45° FOV, retinal fundus photograph.
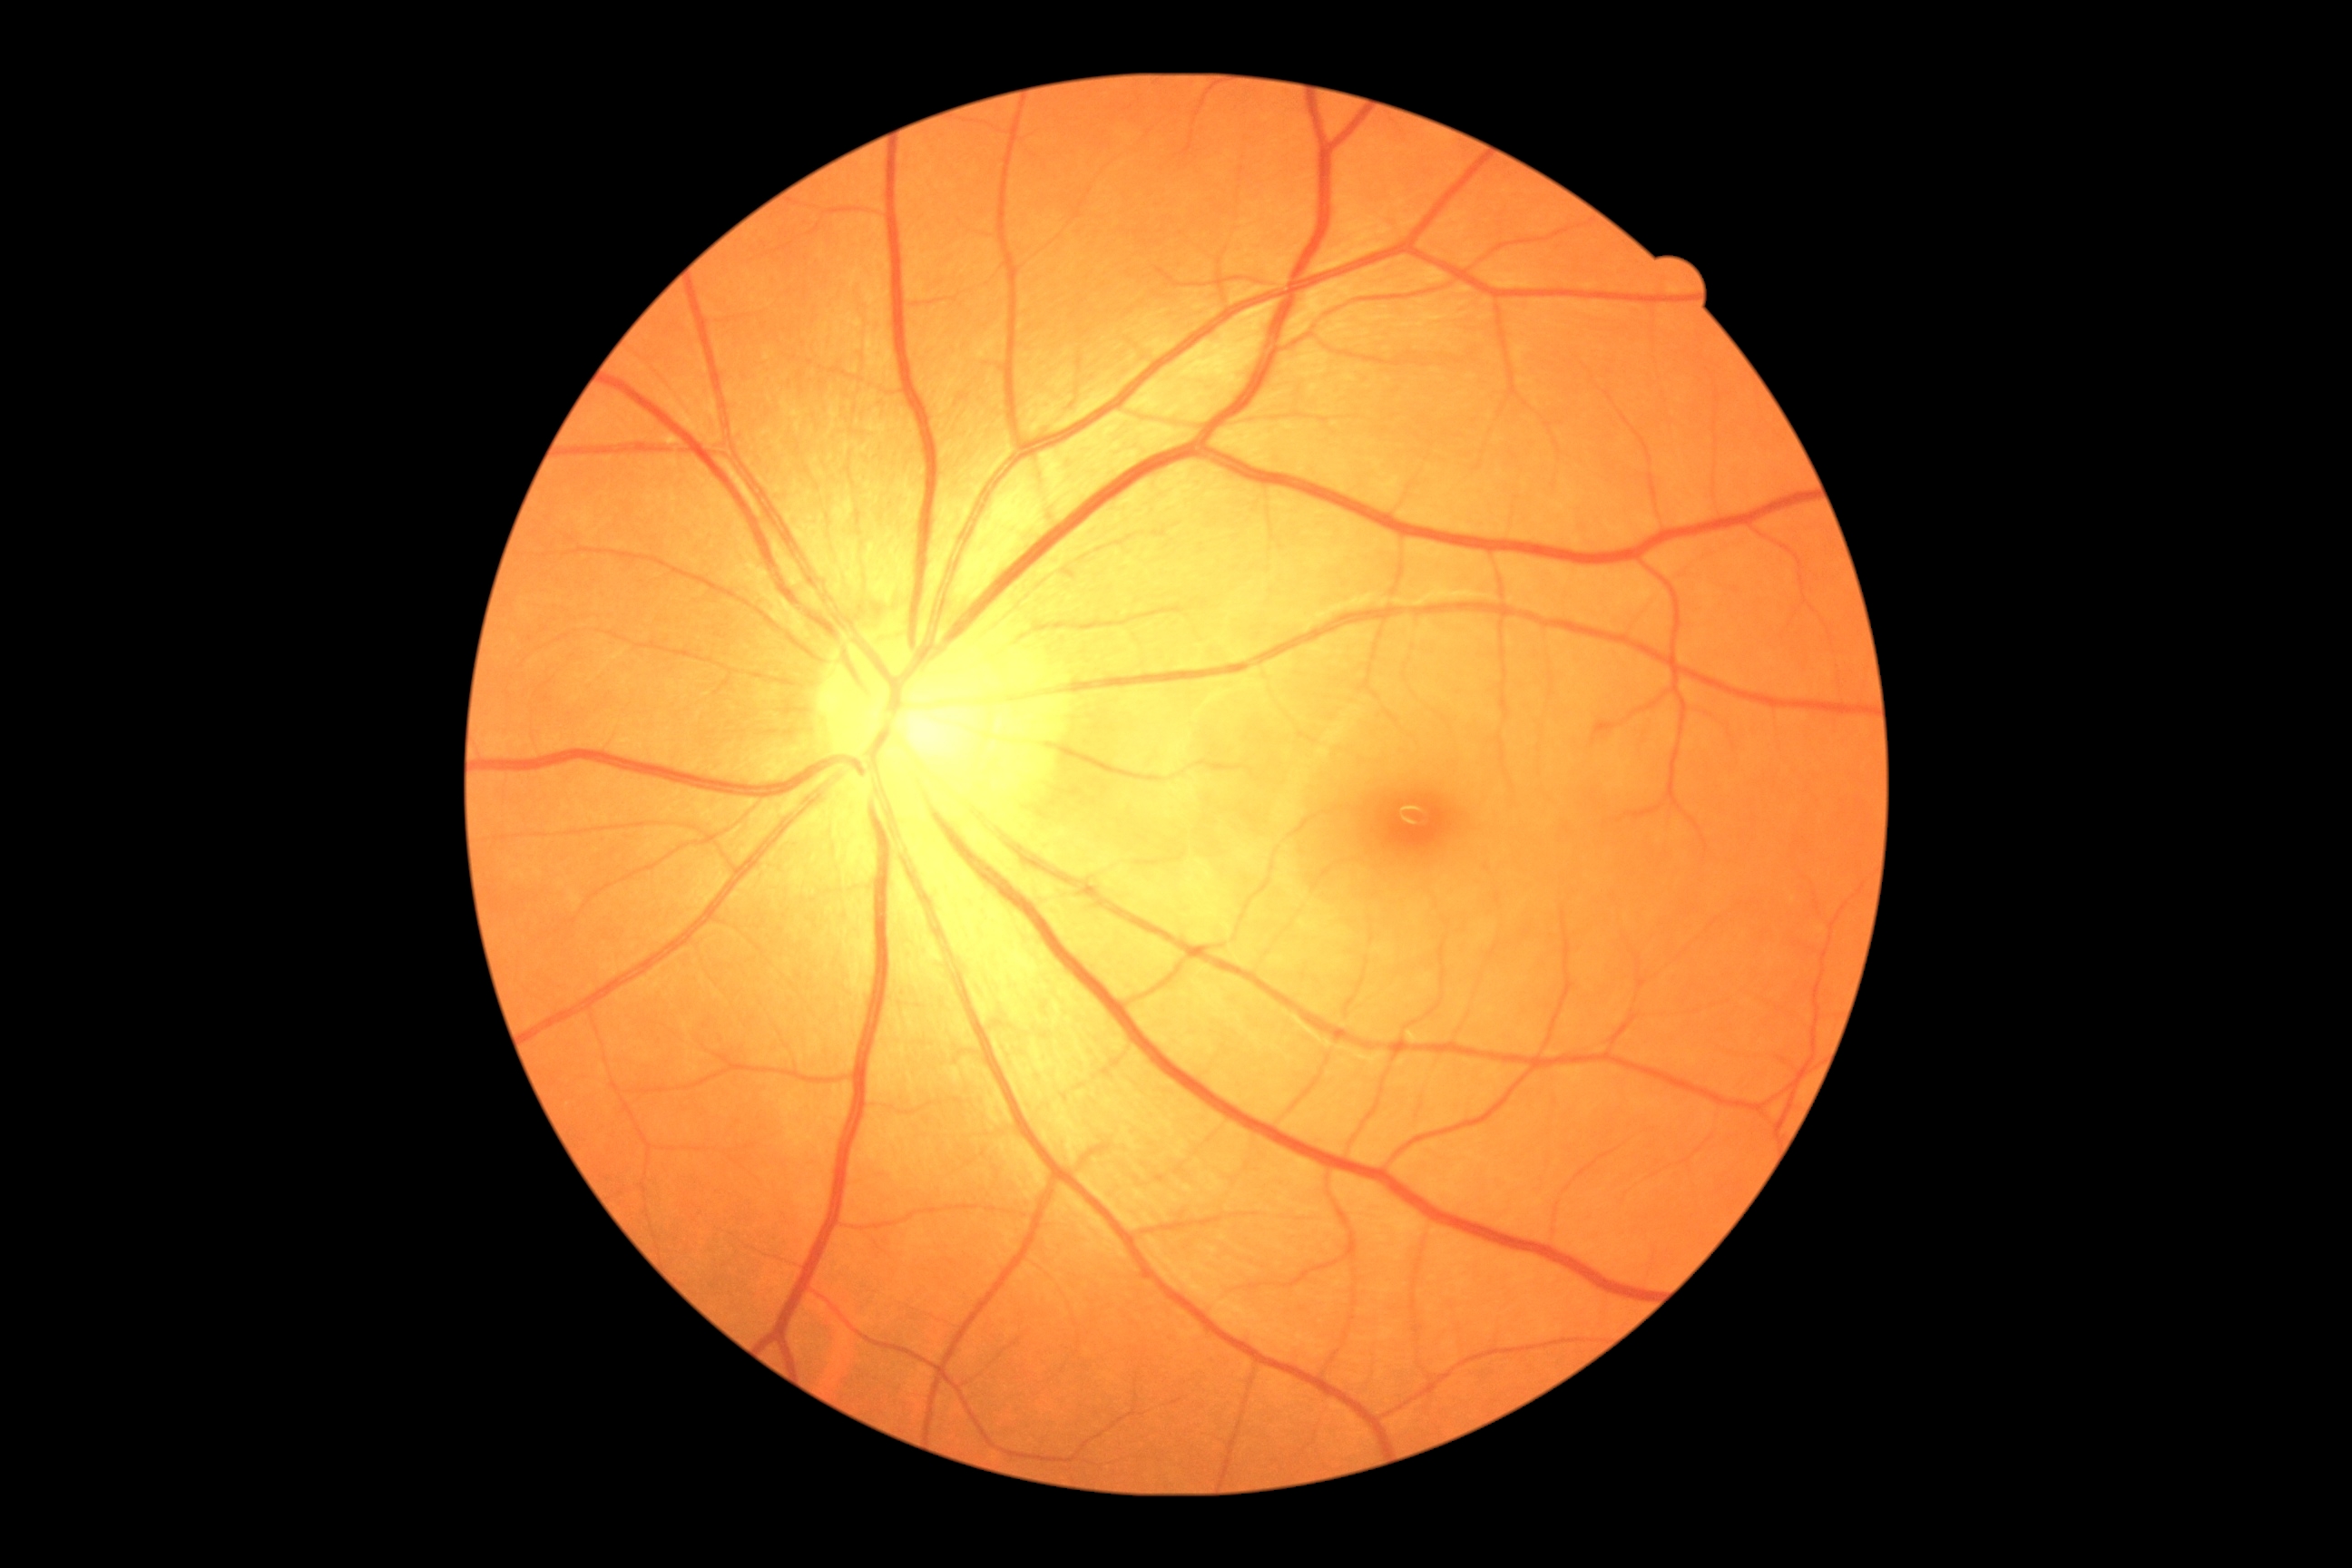 diabetic retinopathy (DR): 0/4, DR impression: no apparent DR.